45° FOV, 2352 x 1568 pixels:
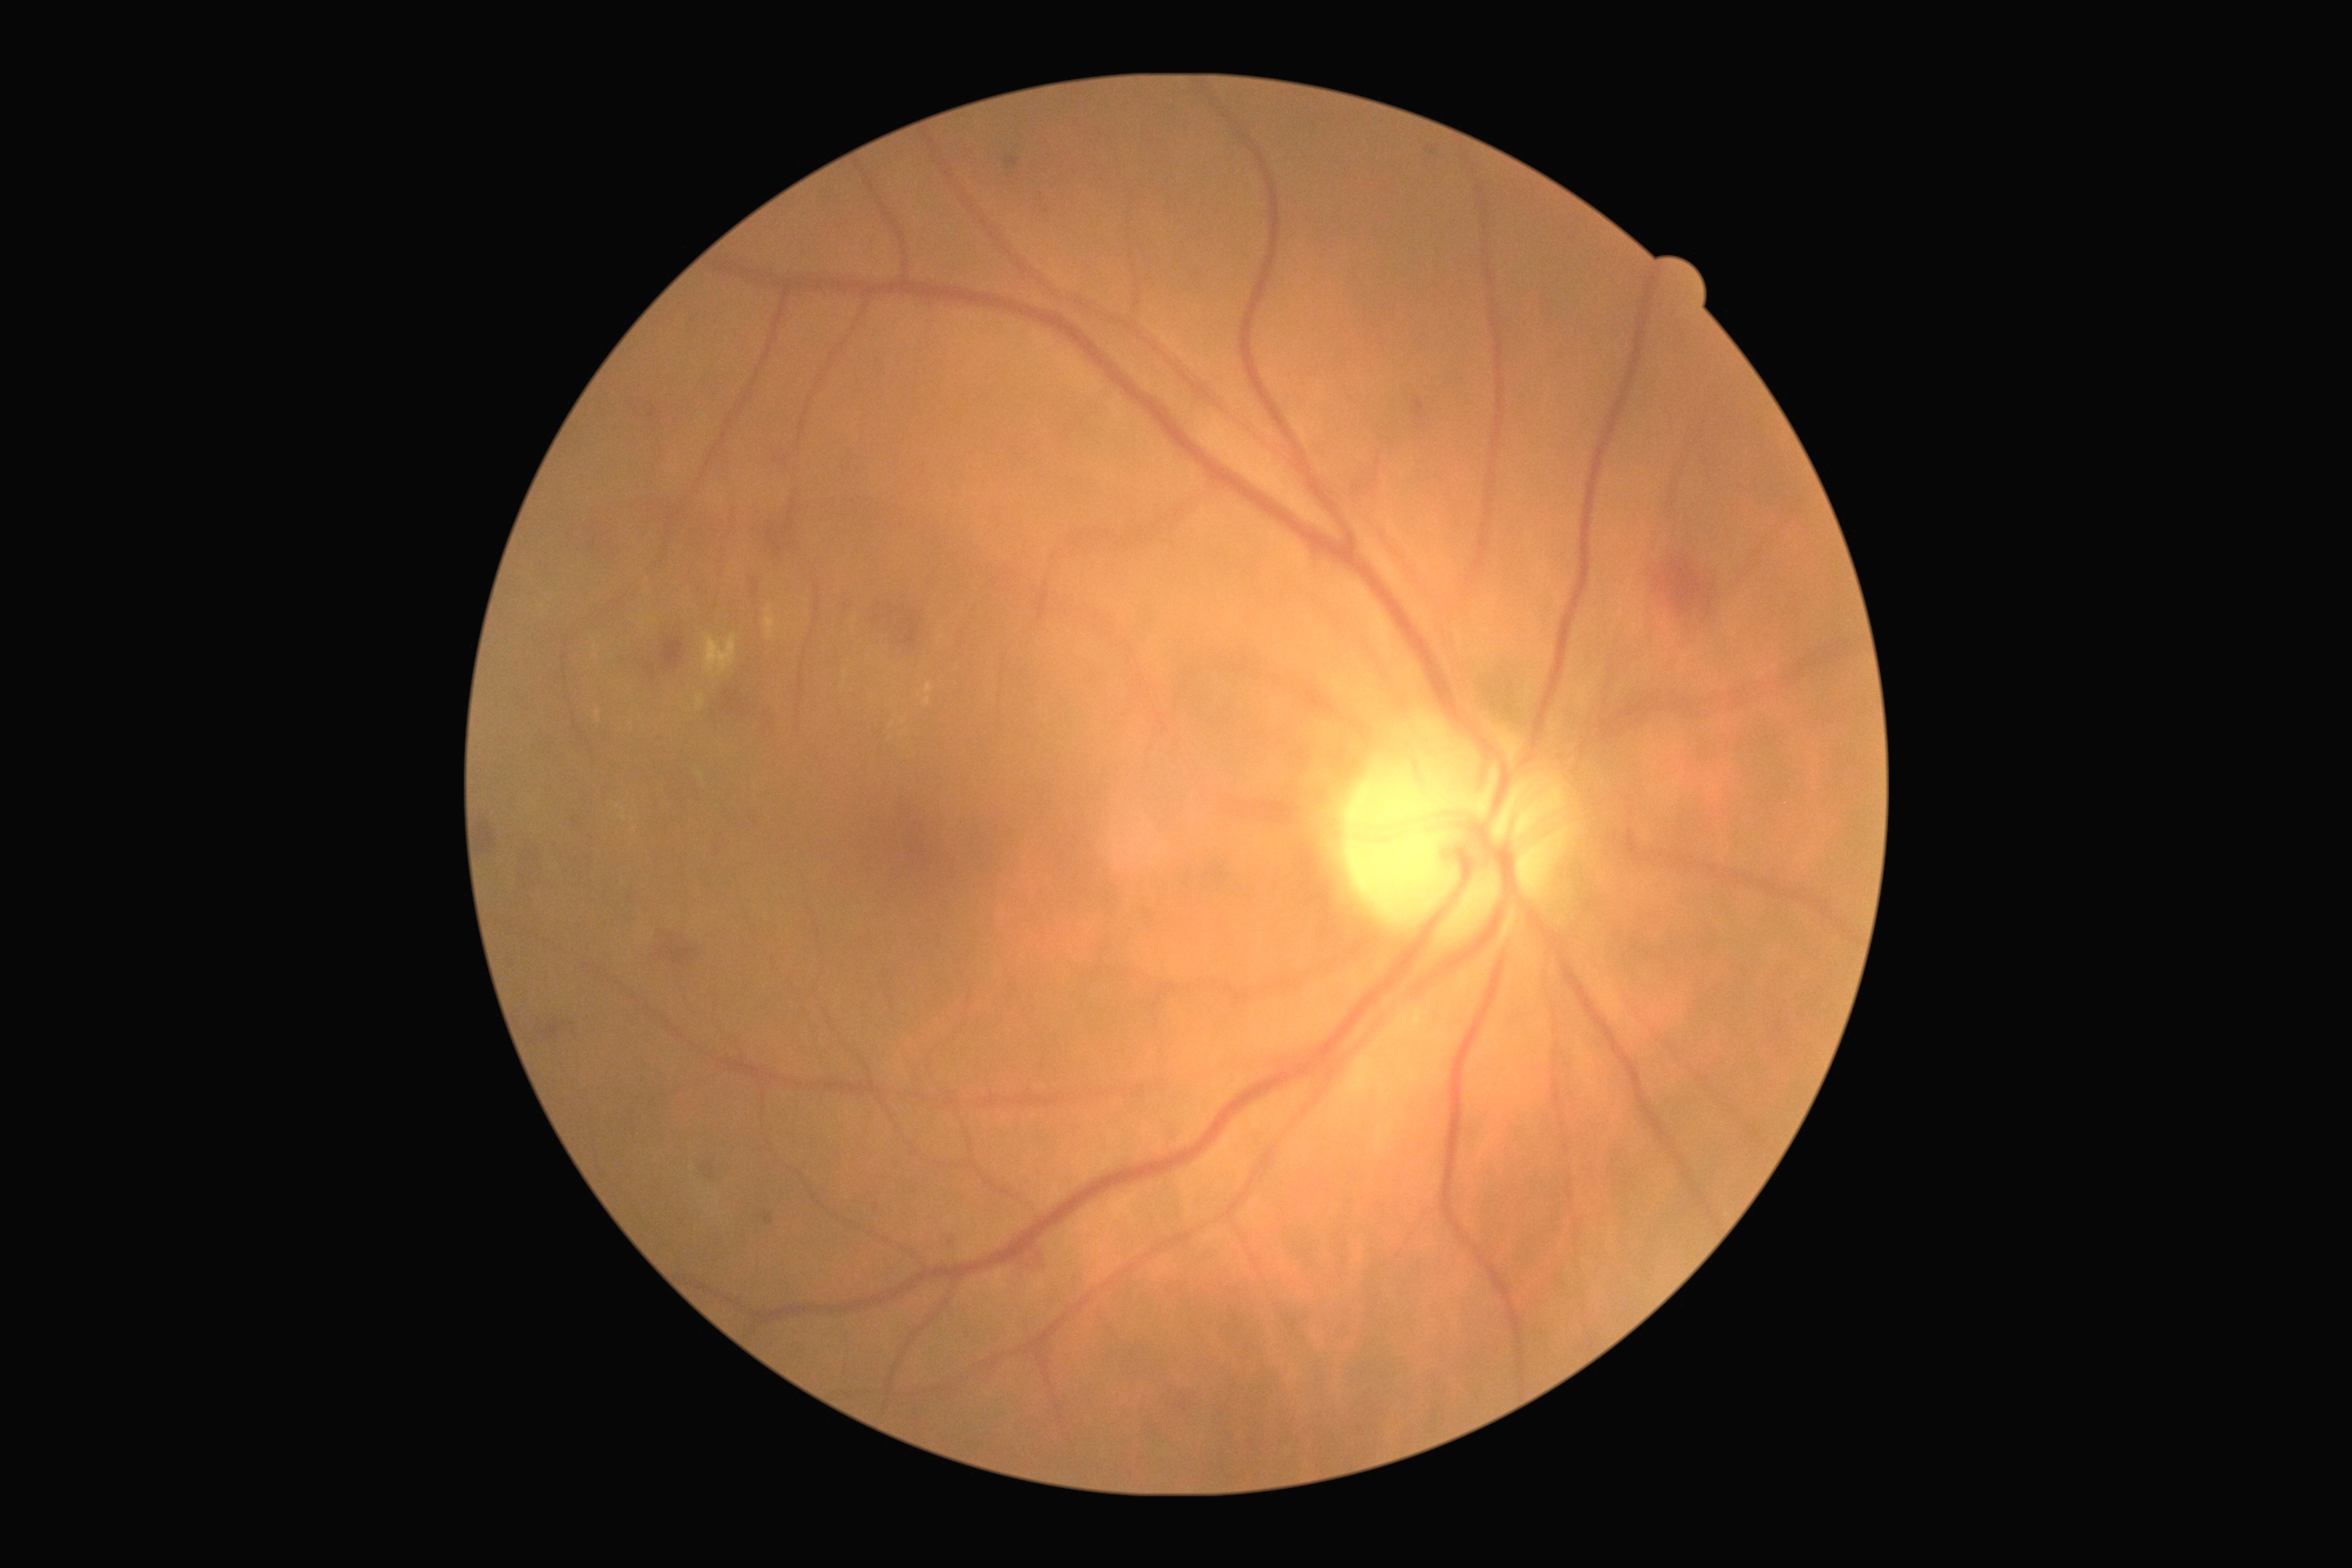

{
  "dr_grade": "moderate non-proliferative diabetic retinopathy (grade 2)"
}